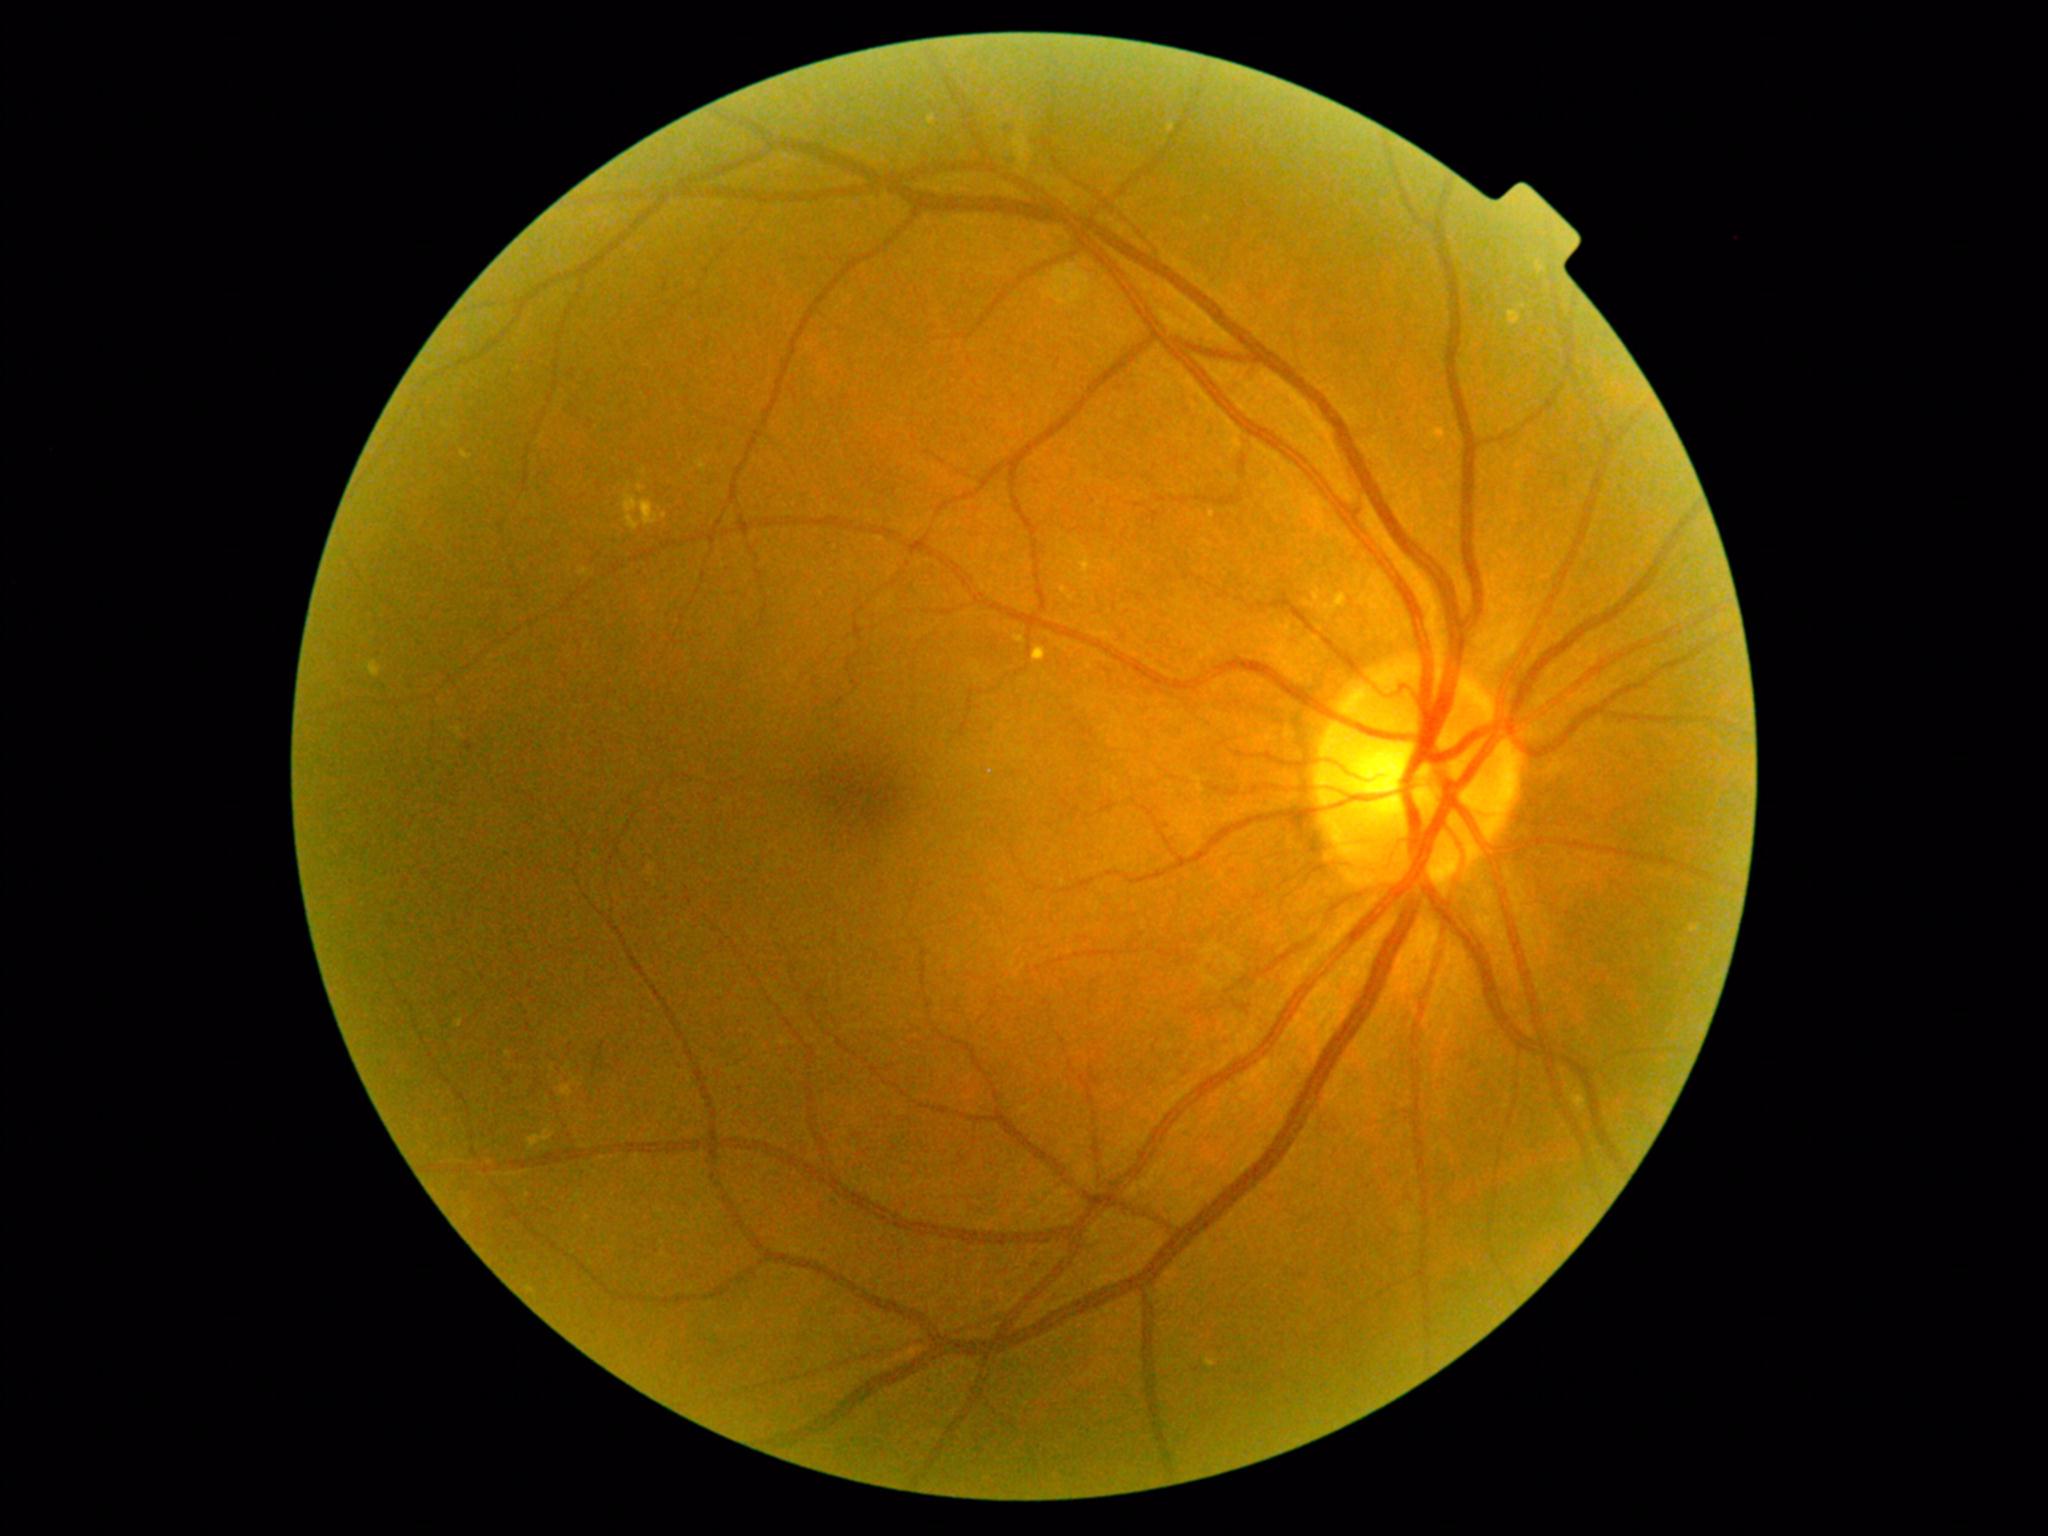
<lesions partial="true">
  <dr_grade>2</dr_grade>
  <ex partial="true"><region>638, 483, 645, 493</region>, <region>1536, 261, 1548, 274</region>, <region>1209, 510, 1216, 519</region>, <region>1439, 427, 1443, 436</region>, <region>528, 1126, 555, 1150</region>, <region>1168, 122, 1176, 133</region>, <region>696, 460, 707, 473</region>, <region>1508, 310, 1522, 326</region>, <region>1571, 1090, 1578, 1104</region>, <region>928, 115, 937, 126</region></ex>
  <ex_small>pt(508, 1054), pt(629, 485)</ex_small>
</lesions>